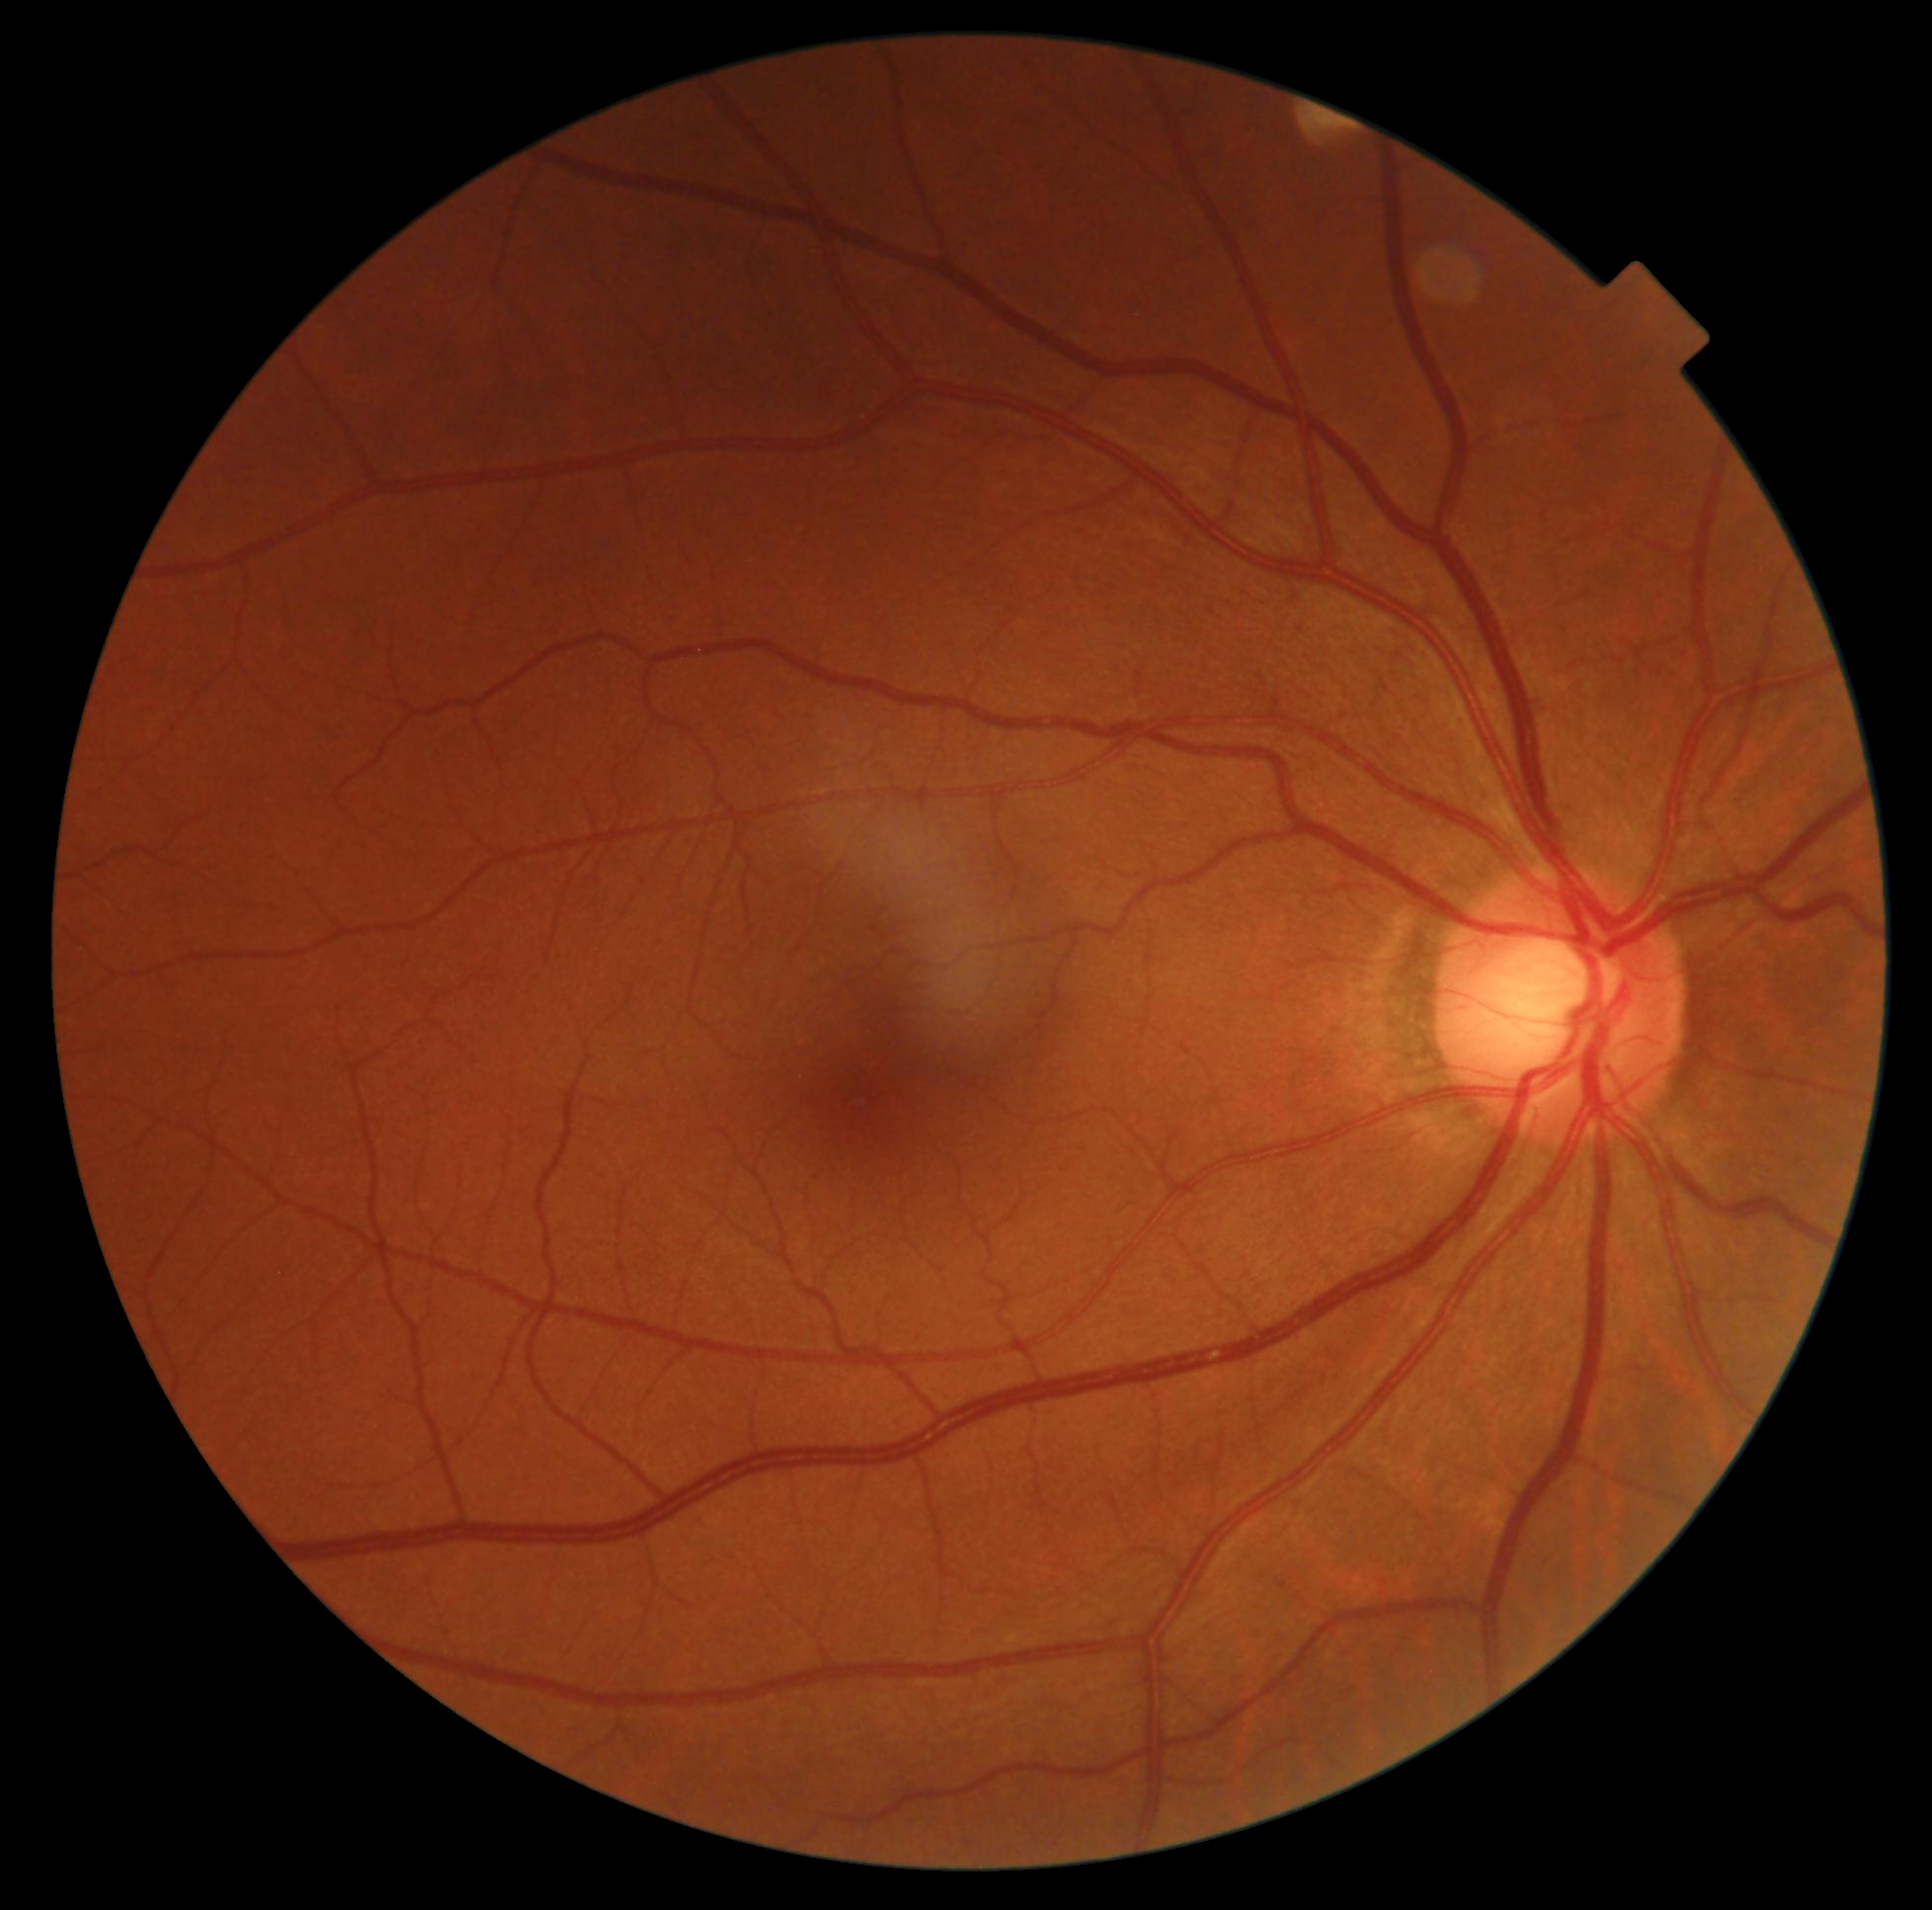

Diabetic retinopathy grade is 0/4. No signs of diabetic retinopathy.